Retinal fundus photograph
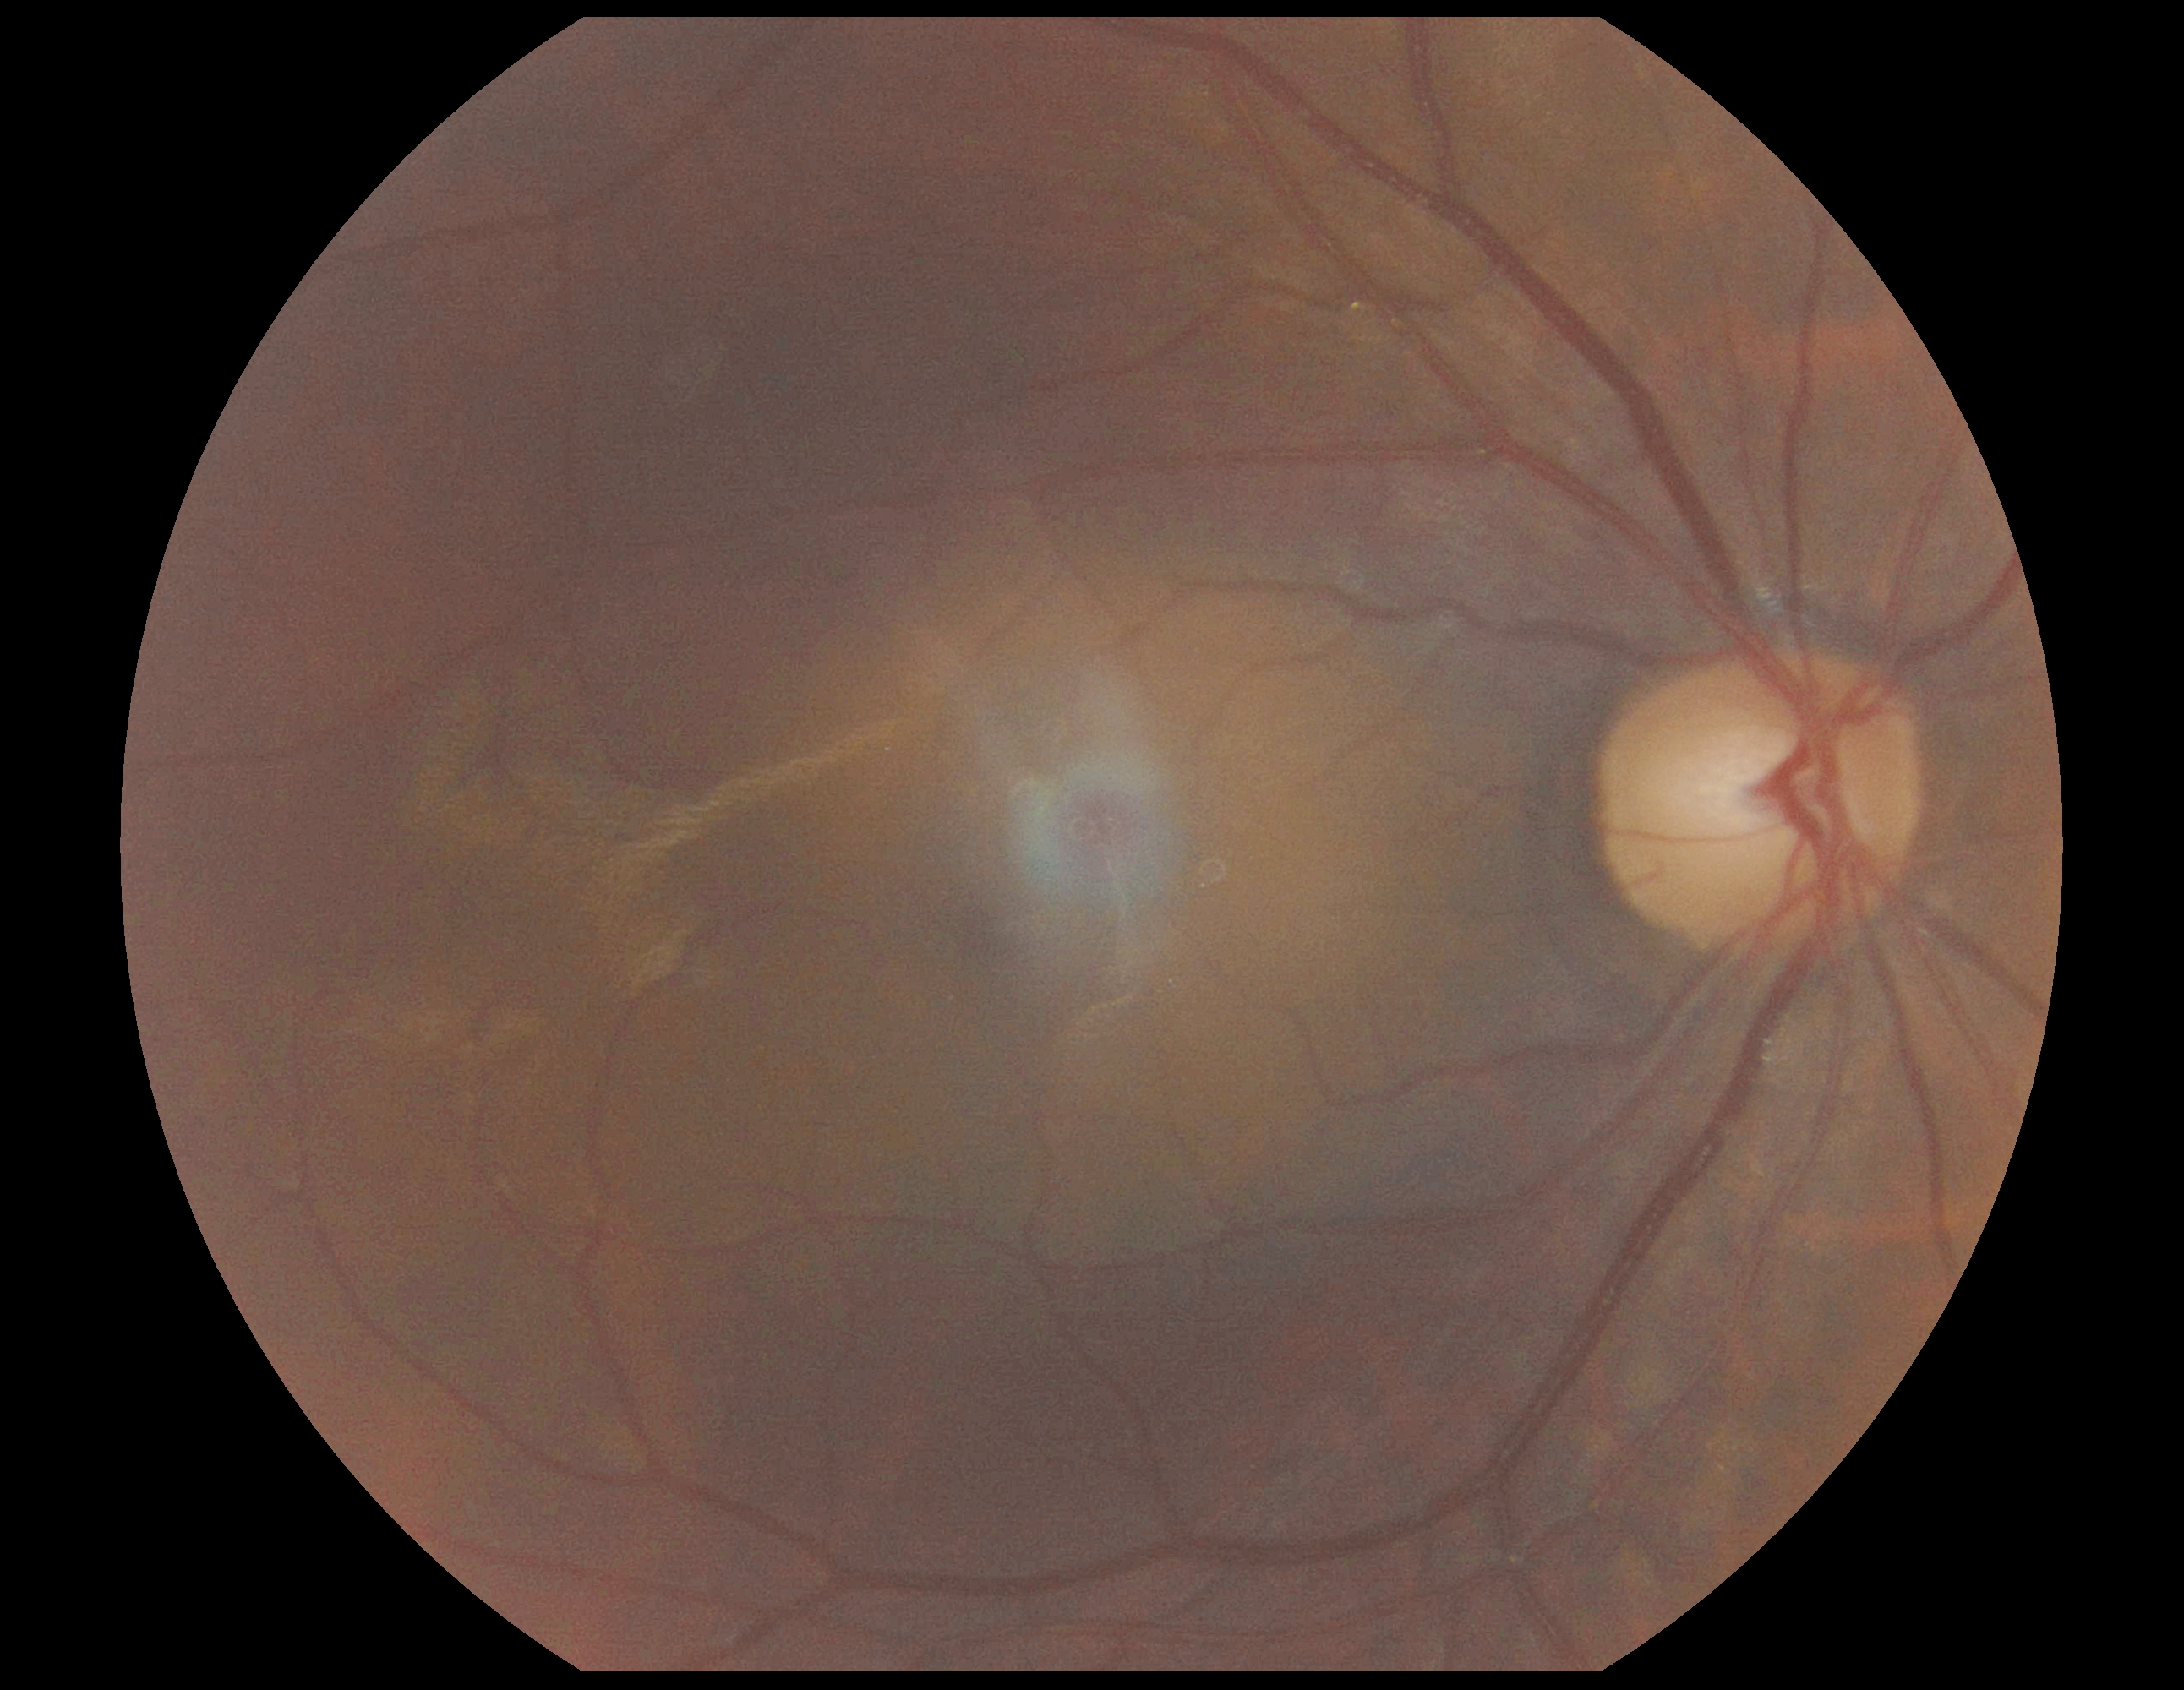

  dr_impression: negative for DR
  dr_grade: 0